Retinal fundus photograph; 1960 x 1897 pixels; FOV: 45 degrees.
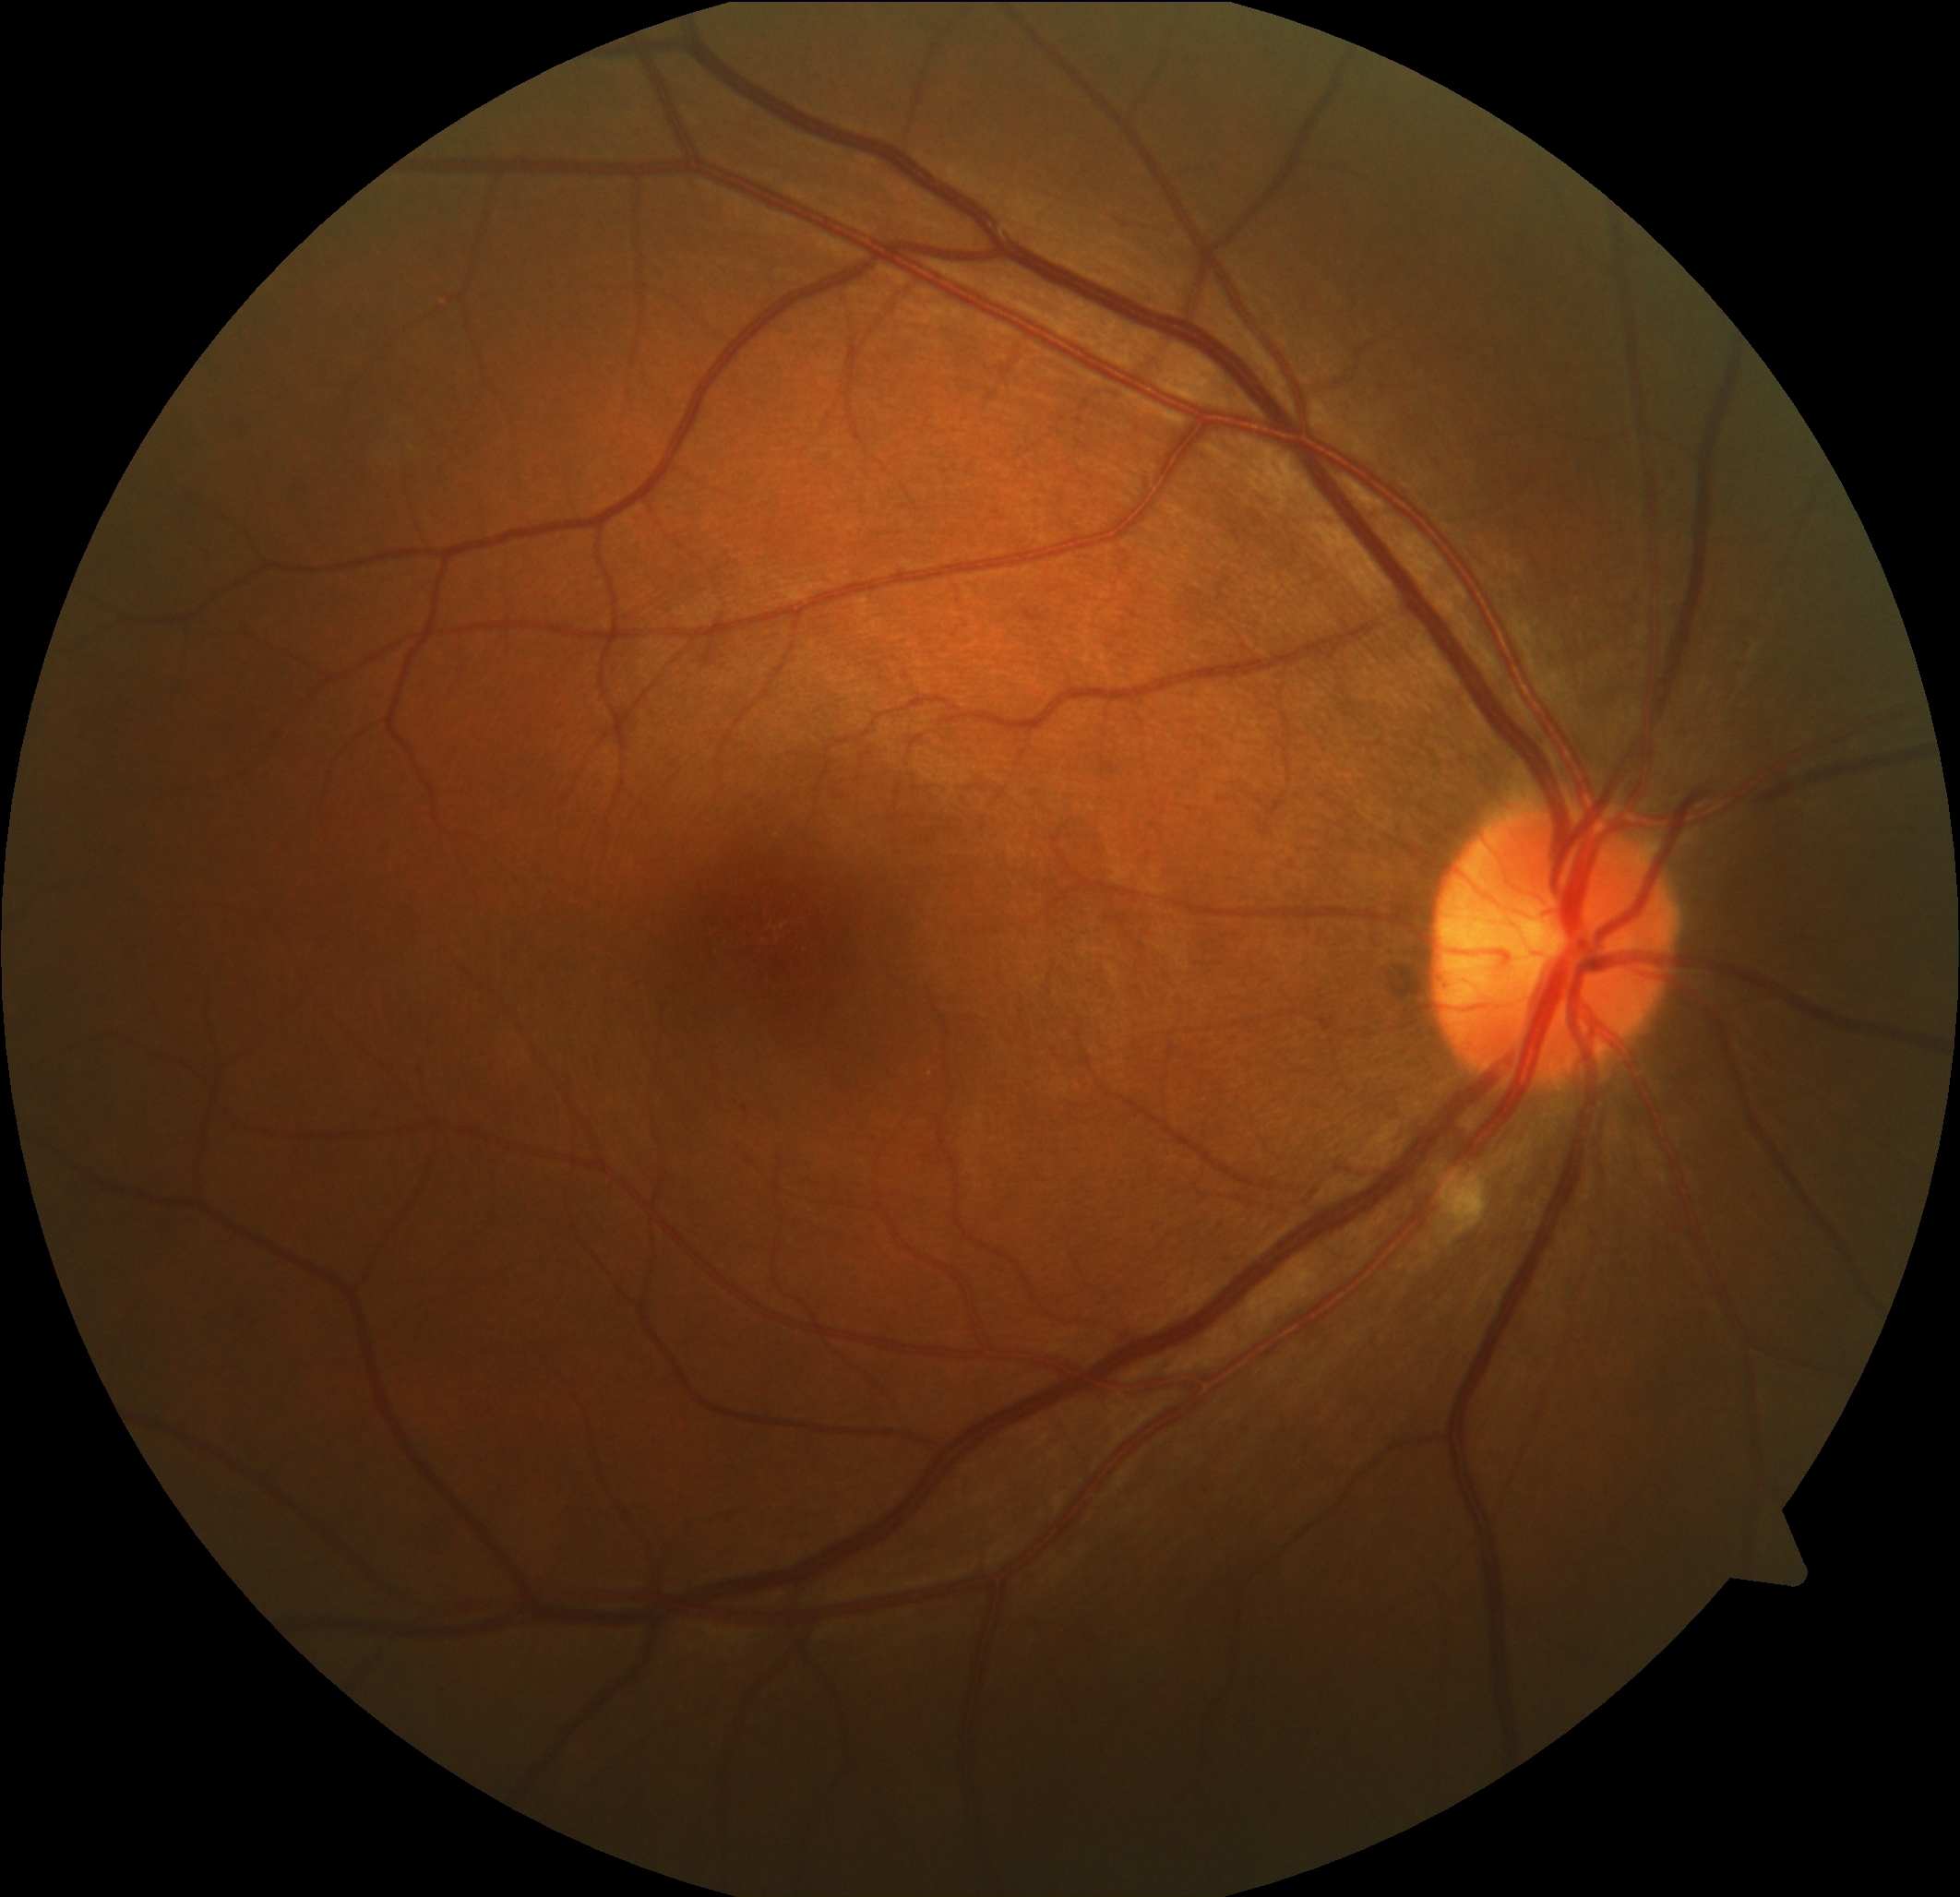

Diabetic retinopathy grade: 2.
DR class: non-proliferative diabetic retinopathy.